45° FOV
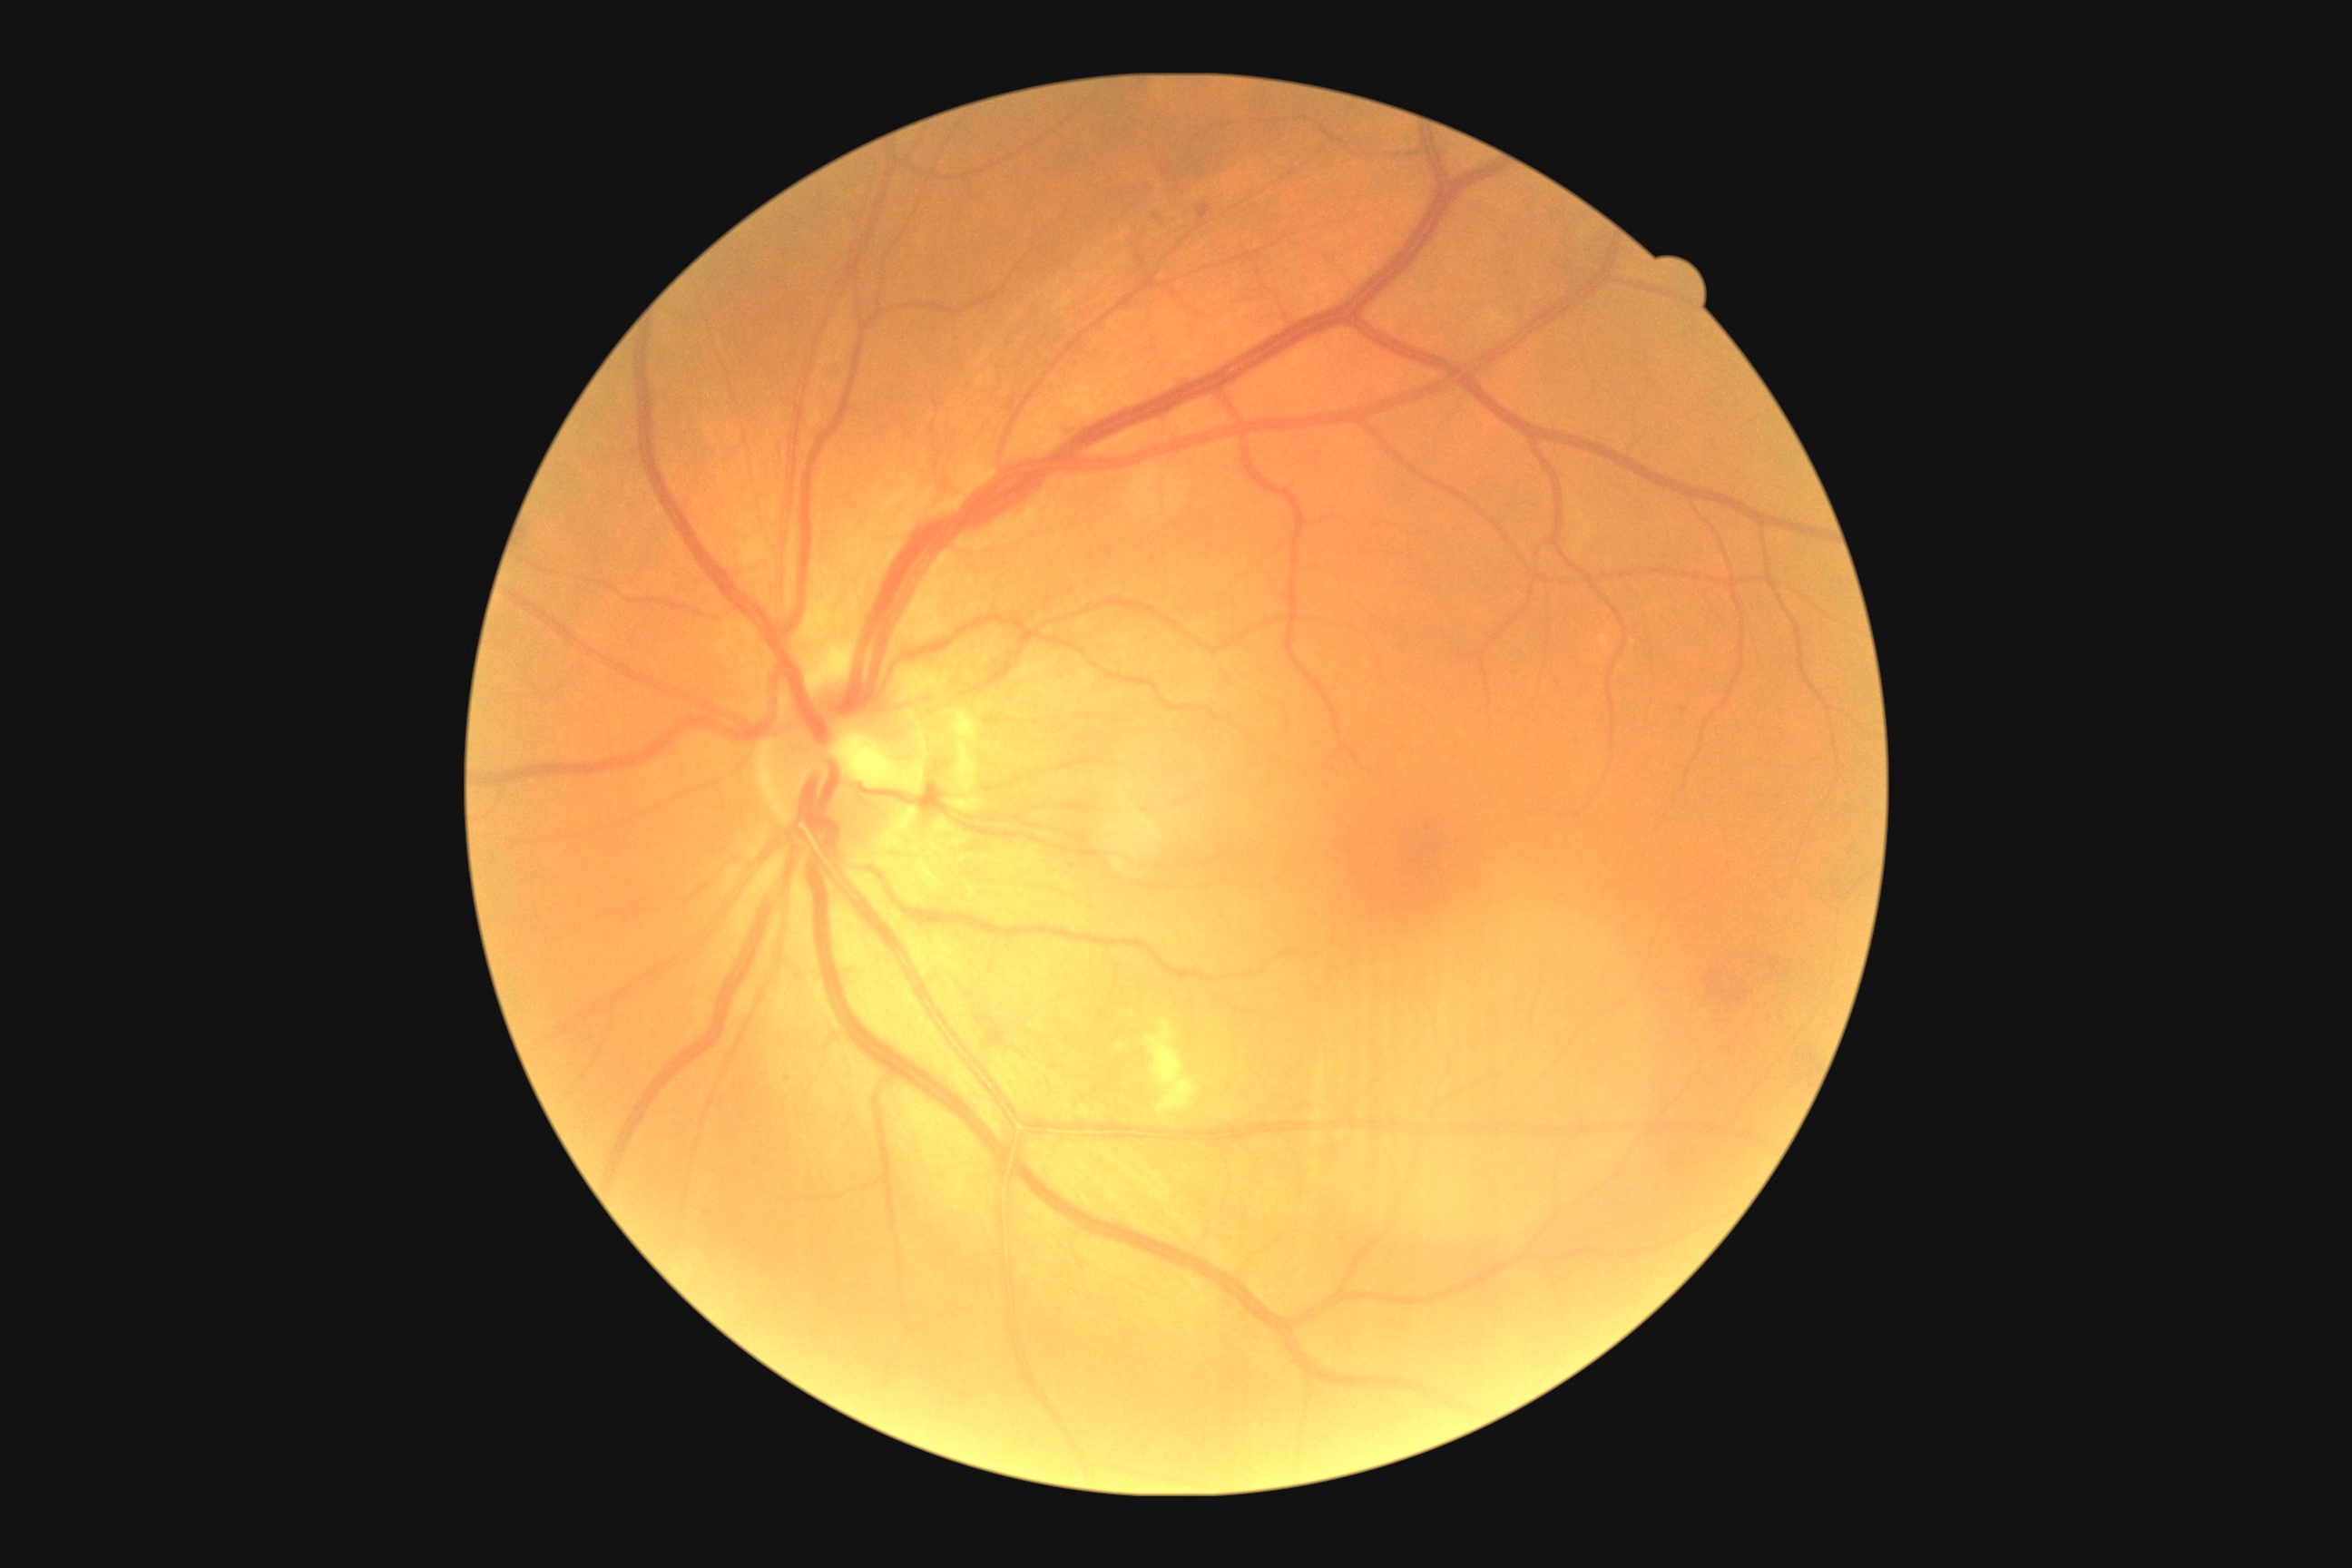
Diabetic retinopathy is moderate non-proliferative diabetic retinopathy (grade 2).